NIDEK AFC-230 fundus camera, without pupil dilation, modified Davis classification
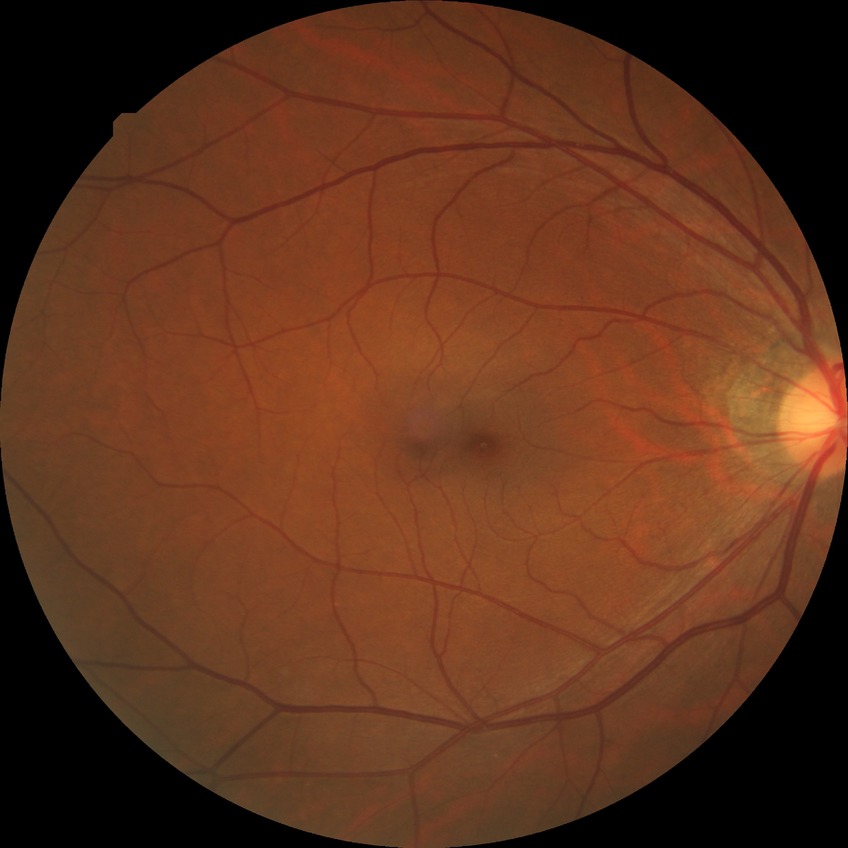 Davis stage = NDR, DR impression = no apparent DR.